Pediatric wide-field fundus photograph; image size 640x480: 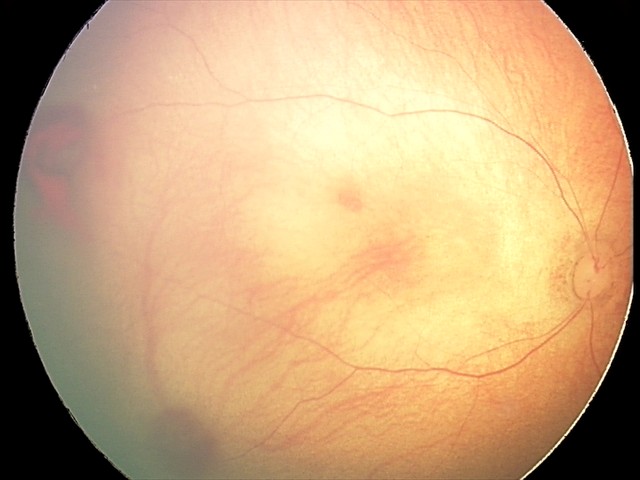

Diagnosis from this screening exam: retinal hemorrhages.